1924 by 1556 pixels · 200° FOV · ultra-widefield fundus mosaic
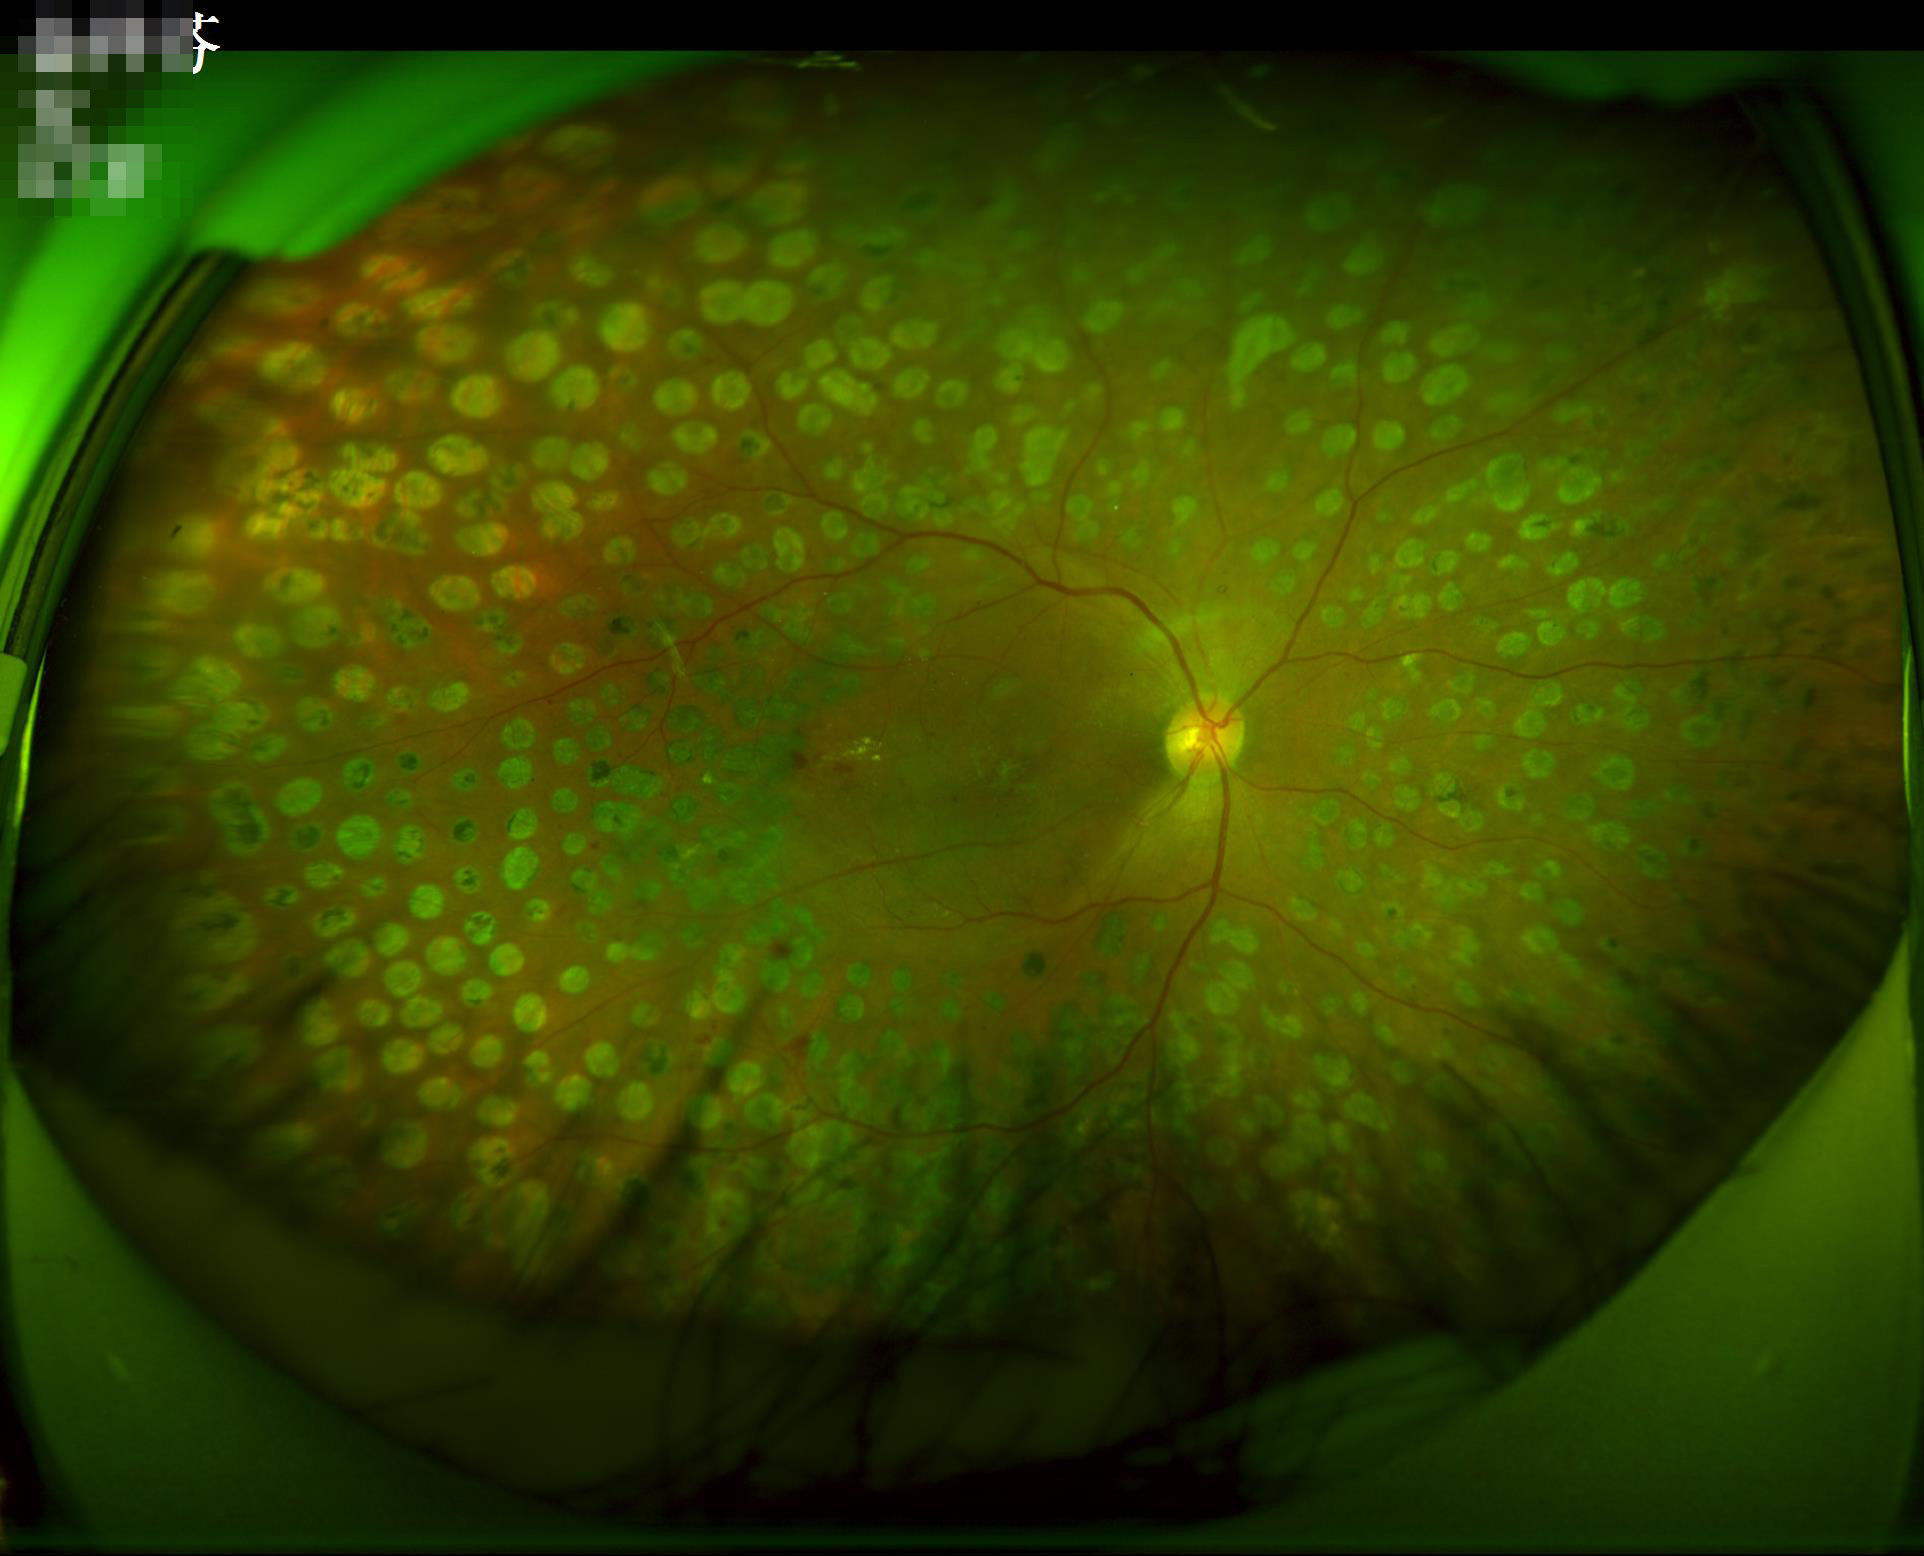
{
  "overall_quality": "good, gradable",
  "clarity": "sharp throughout the field",
  "illumination": "over- or under-exposed"
}